848 by 848 pixels · modified Davis classification
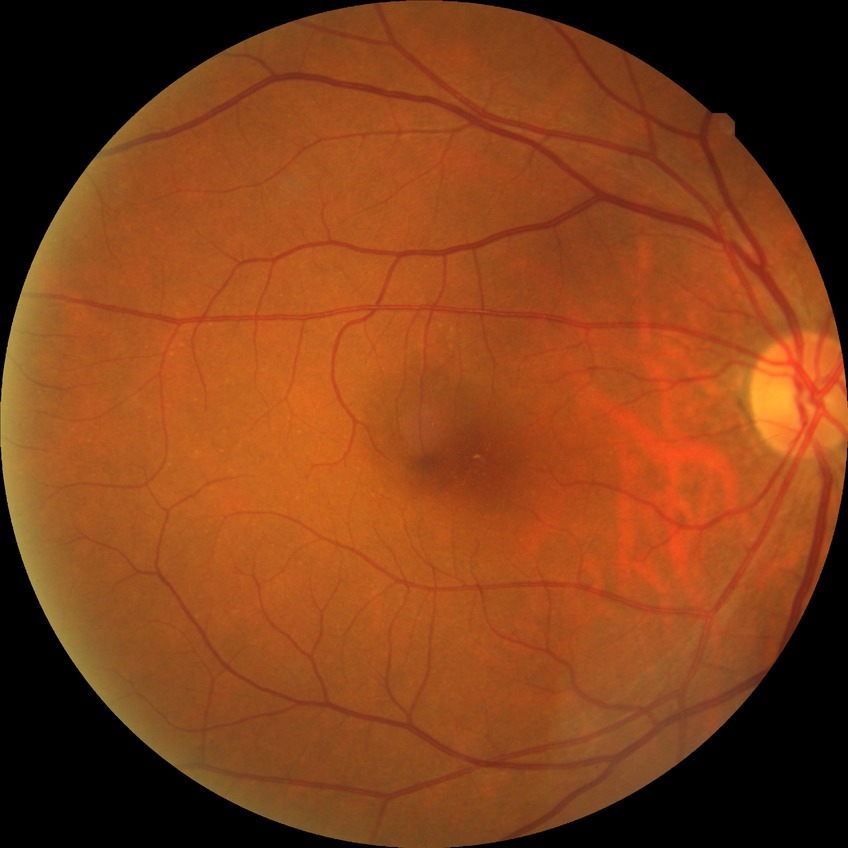

Diabetic retinopathy (DR) is NDR (no diabetic retinopathy).